Image size 1932x1932: 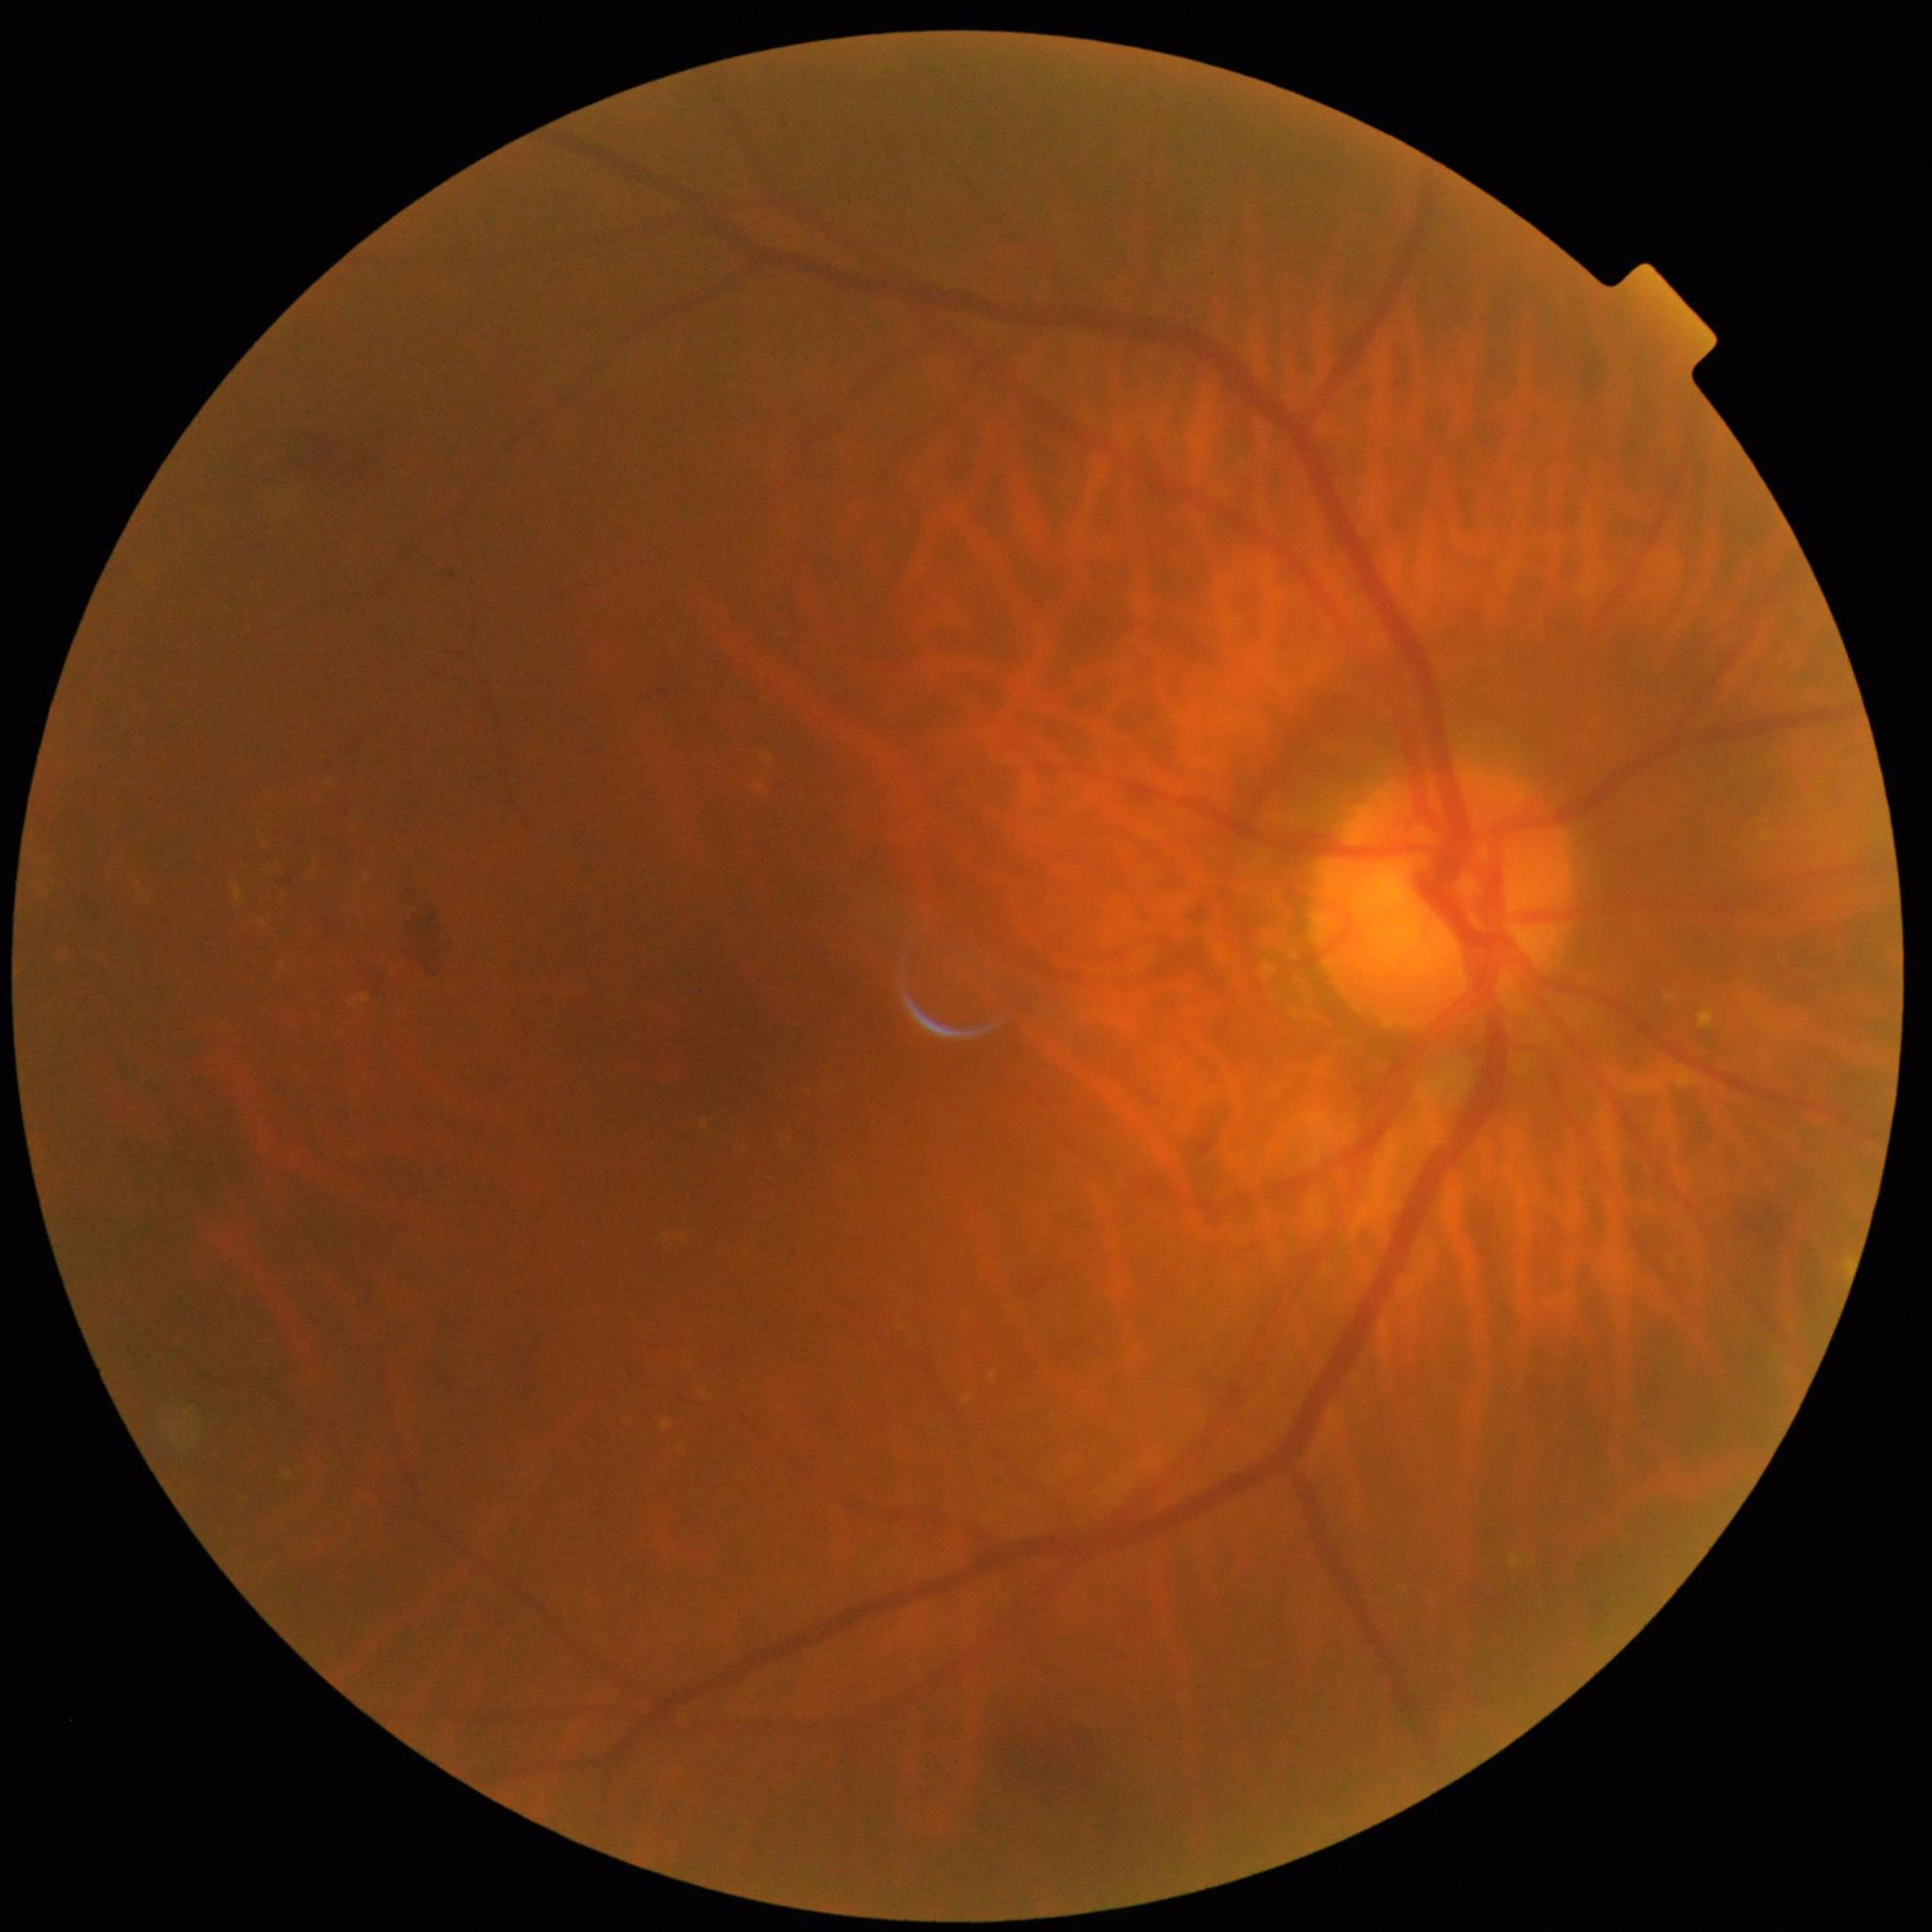

Quality assessment: concerns include blur. Eye affected by diabetic retinopathy (DR).